Wide-field fundus photograph of an infant:
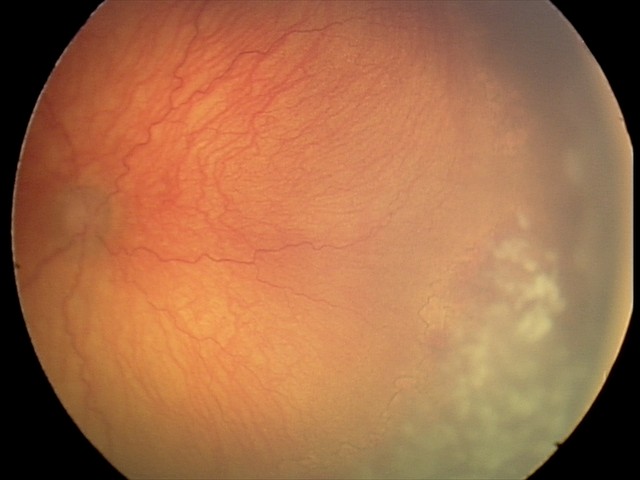 Screening series with aggressive retinopathy of prematurity.